Disc-centered field:
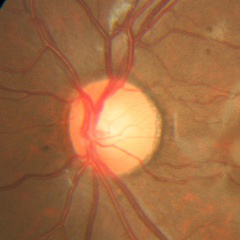 Showing no signs of glaucoma.